Wide-field retinal mosaic image:
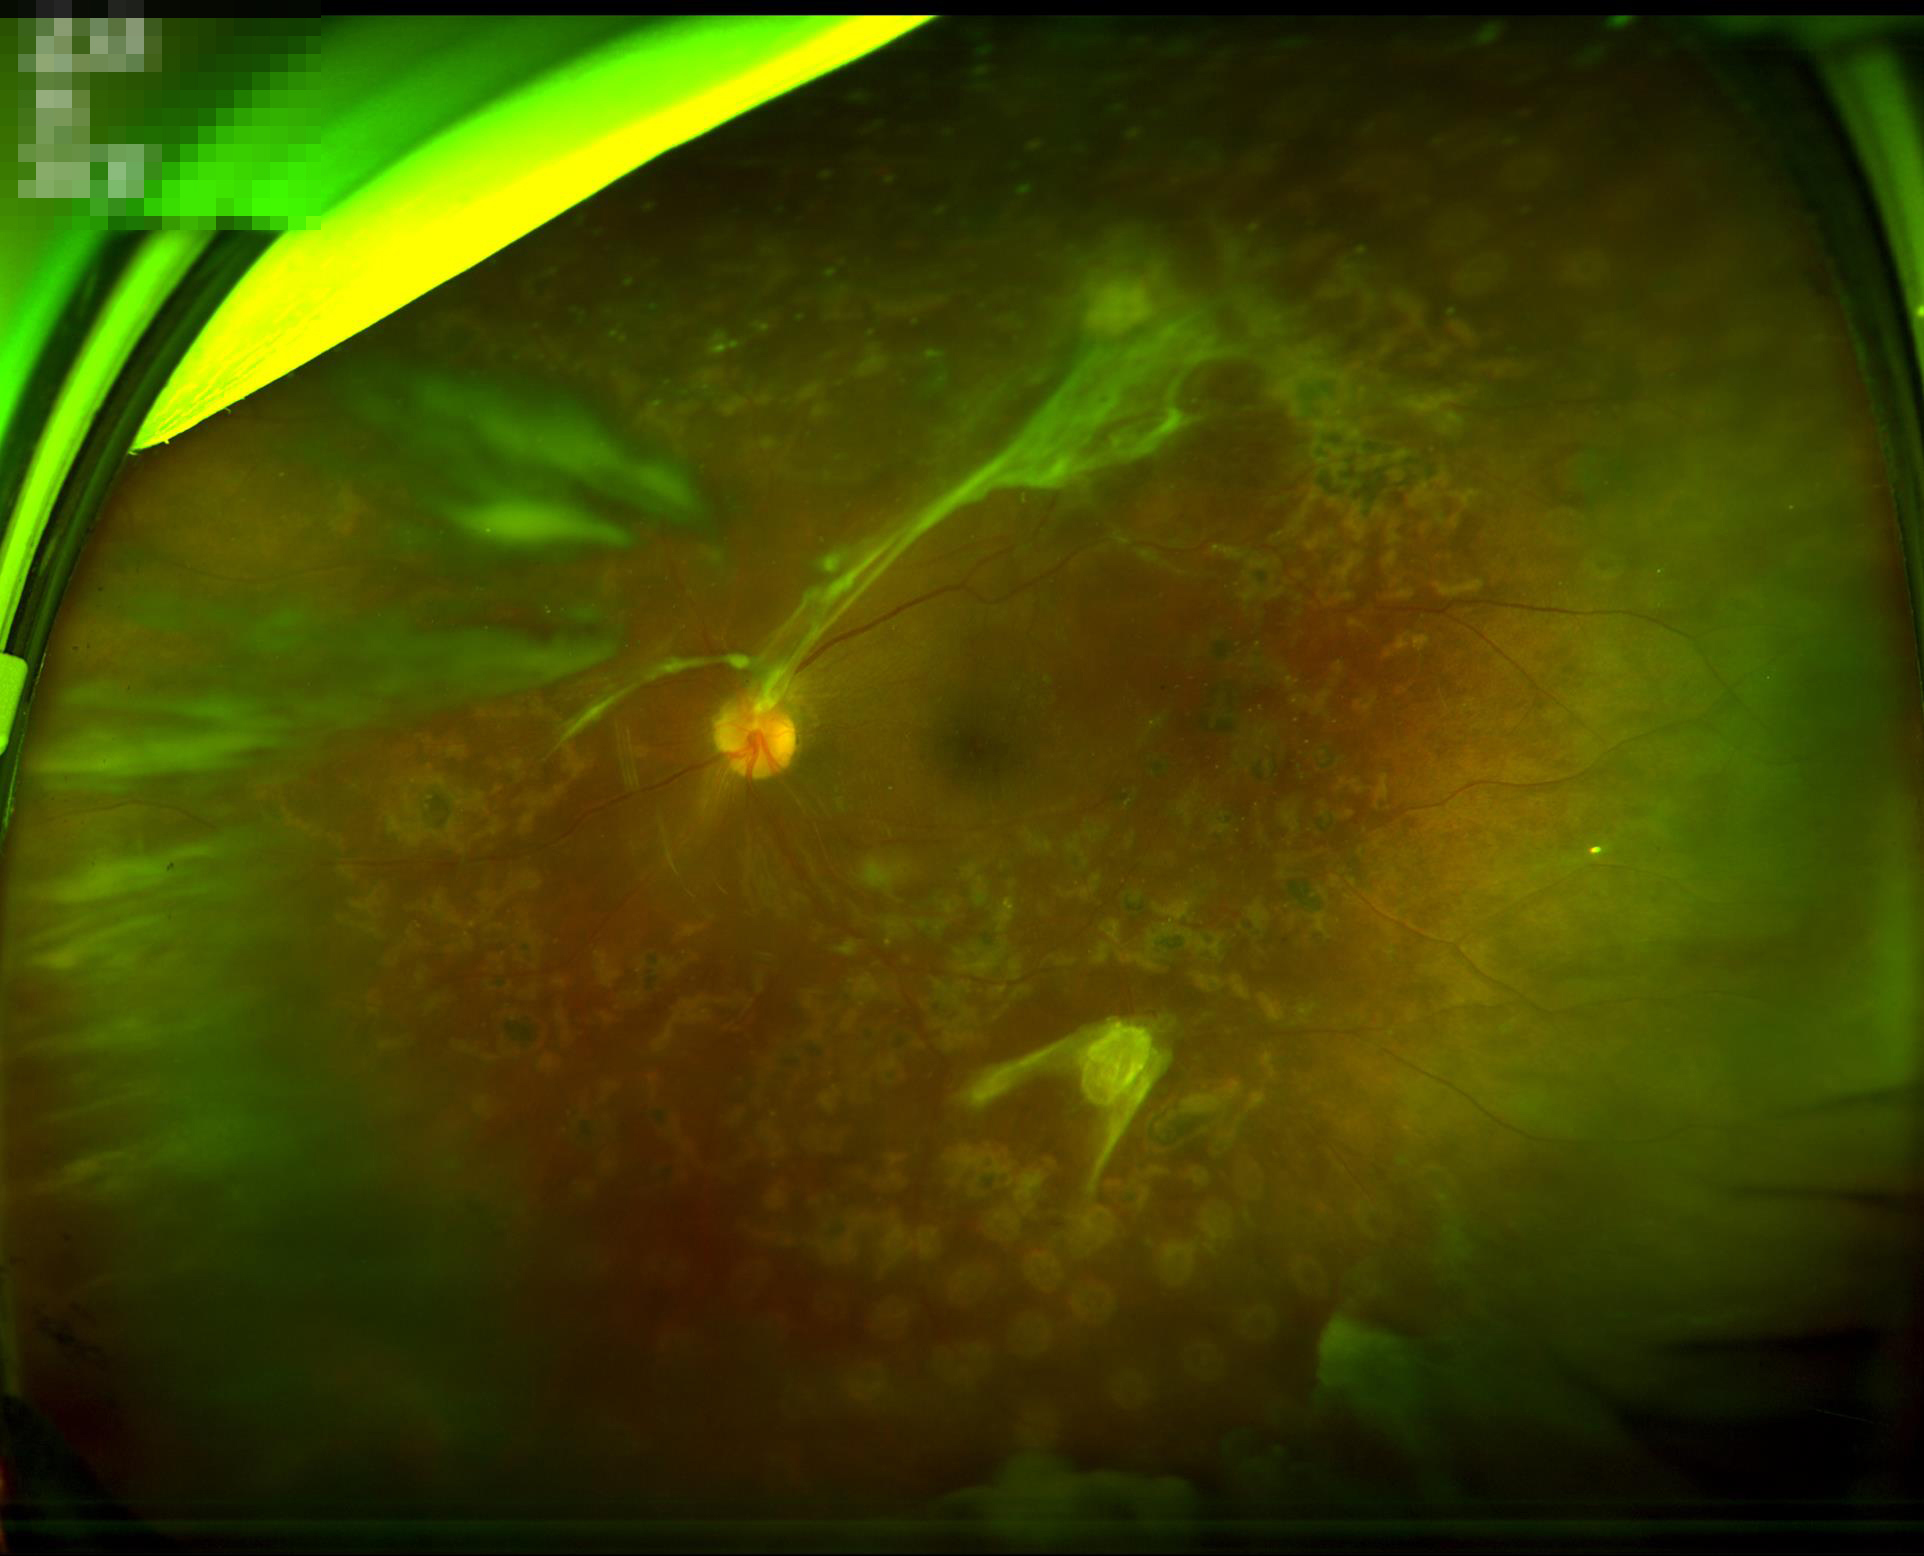
{
  "illumination": "uneven illumination or color cast",
  "contrast": "vessels and details readily distinguishable",
  "overall_quality": "poor, ungradable",
  "clarity": "out of focus, structures indistinct"
}